Color fundus image.
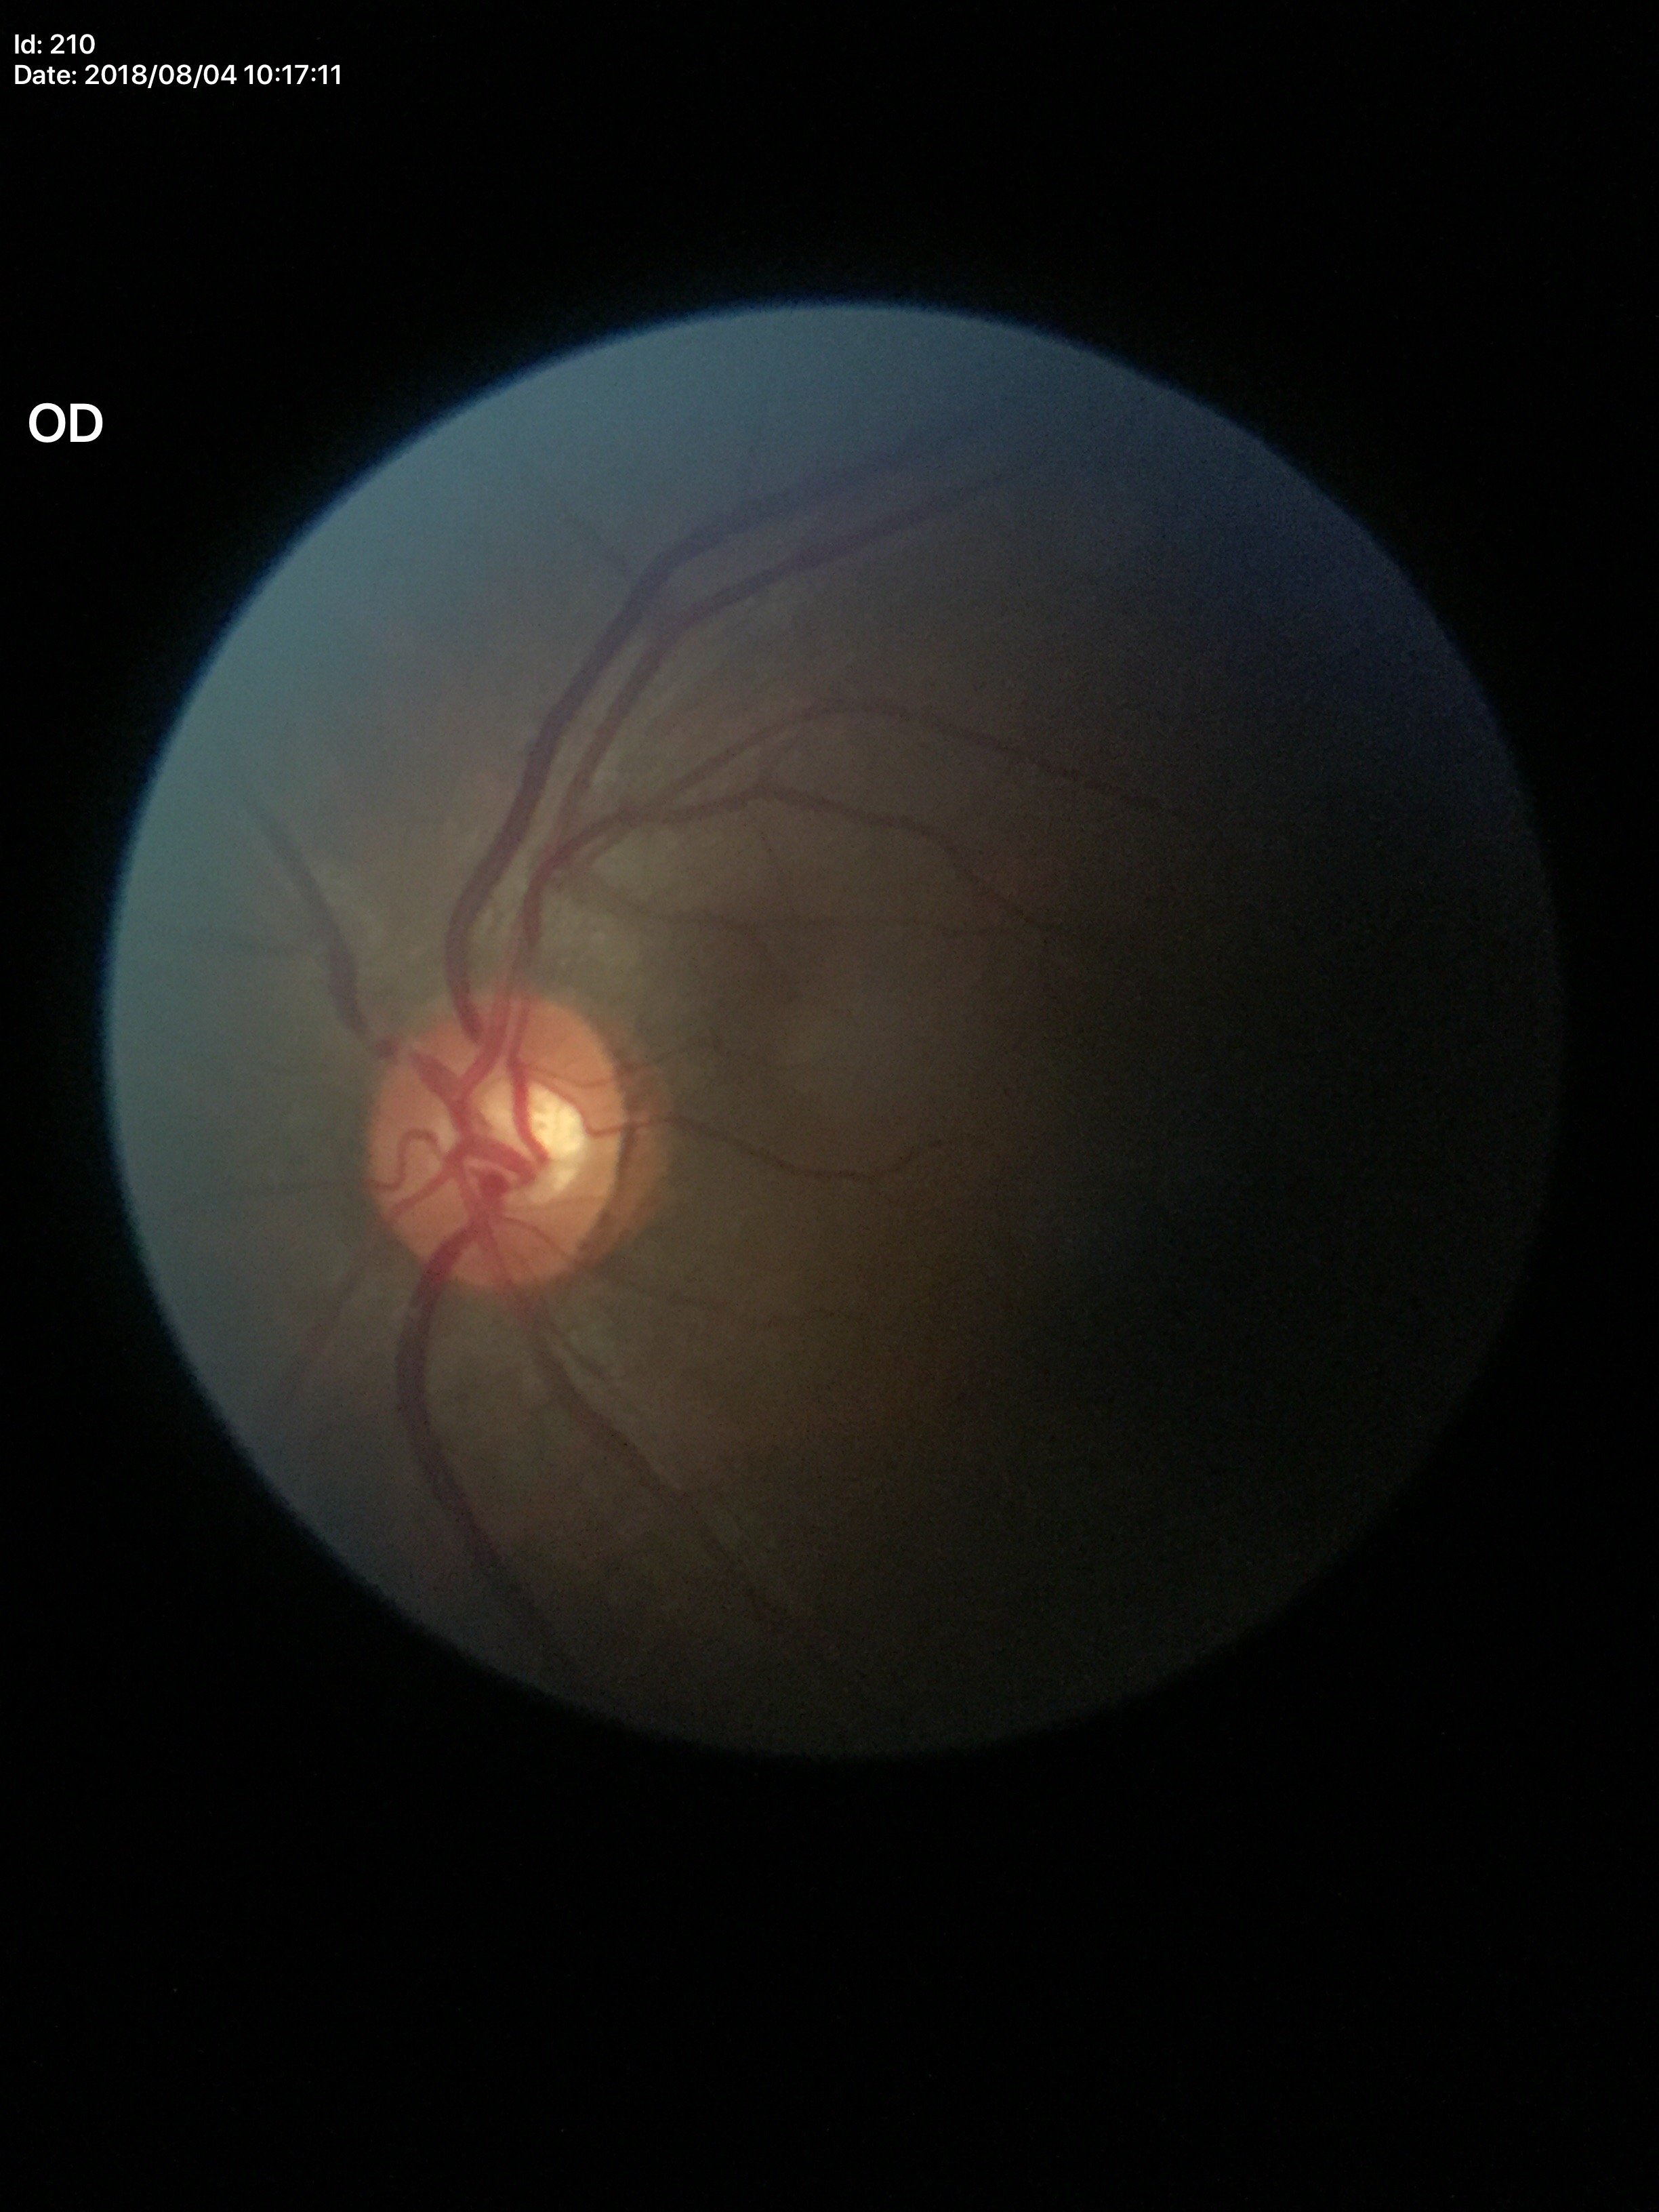 vertical CDR: 0.51, Glaucoma assessment: no suspicious findings (all 5 graders called normal), horizontal CDR: 0.59.